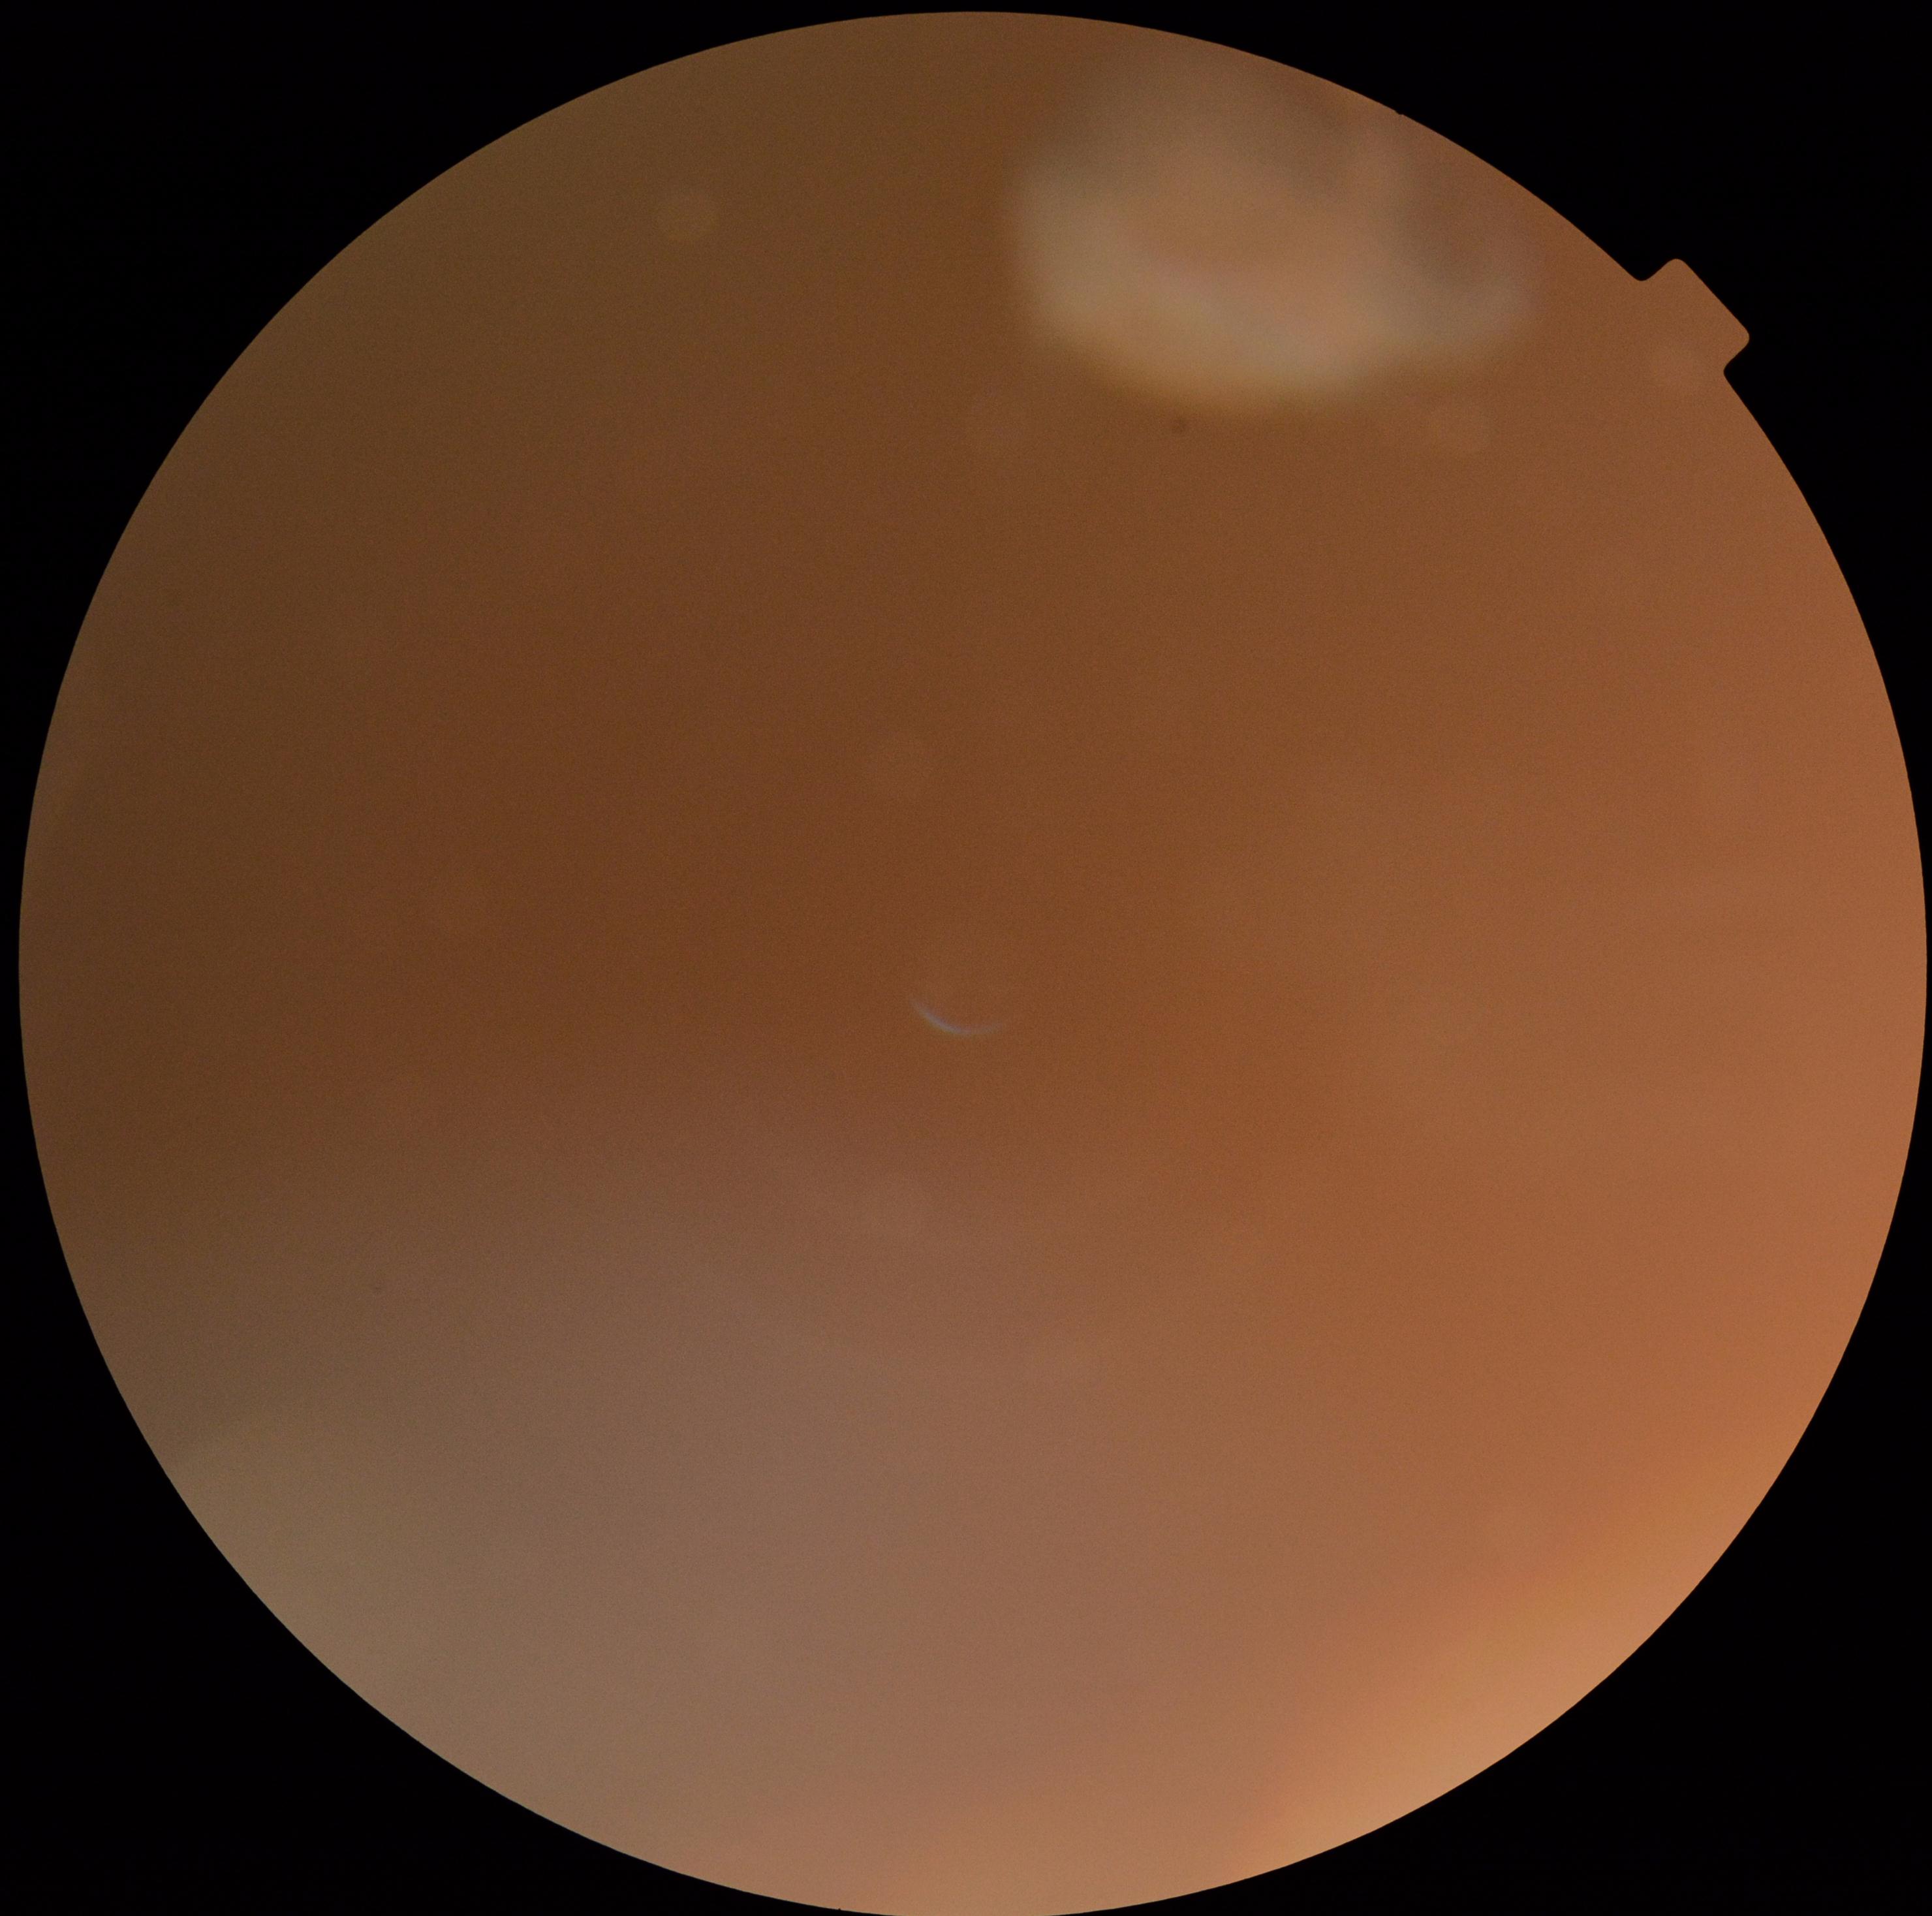
diabetic retinopathy grade: ungradable due to poor image quality.